Pediatric retinal photograph (wide-field).
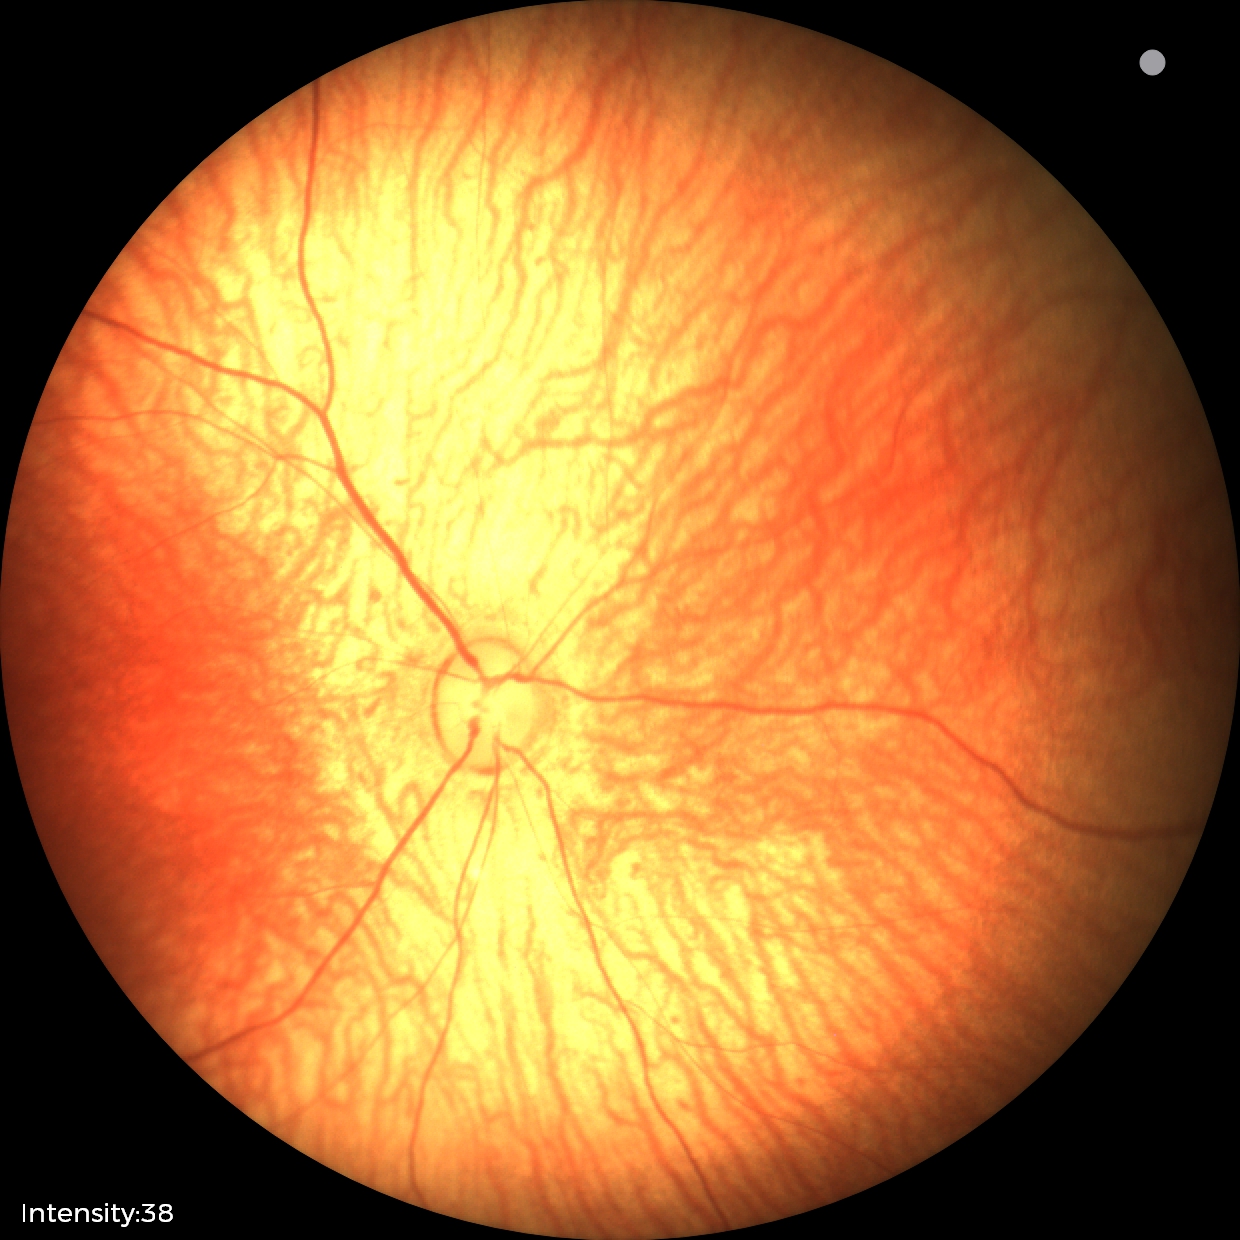 Screening examination with no abnormal retinal findings.